Color fundus photograph. 45 degree fundus photograph. Image size 848x848.
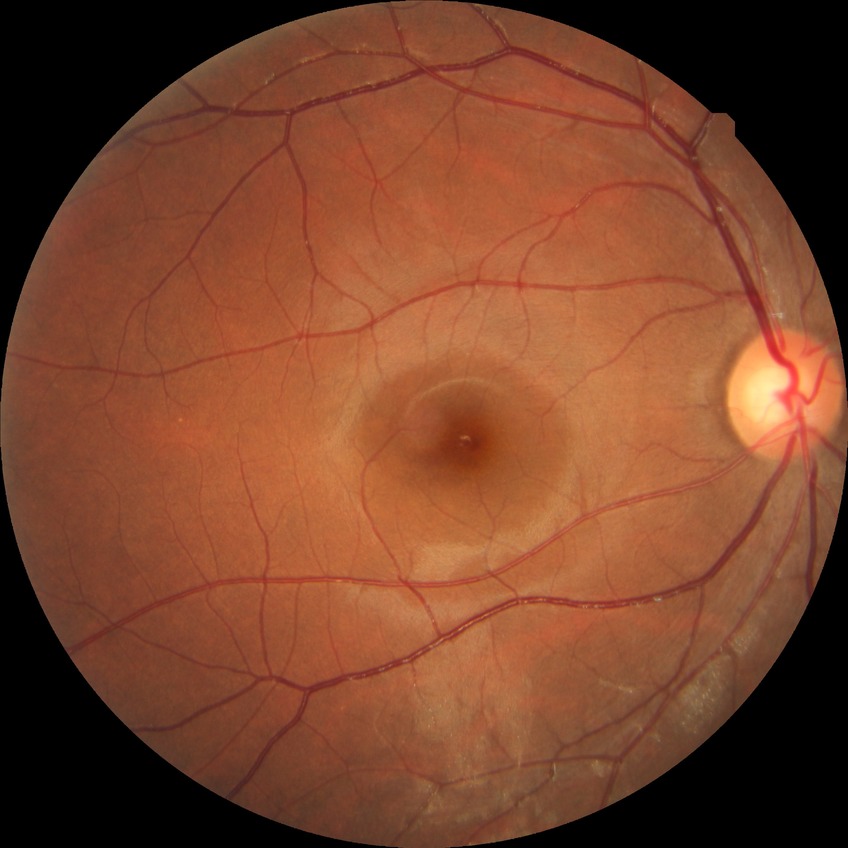 retinopathy stage: no diabetic retinopathy.